Captured after pupil dilation
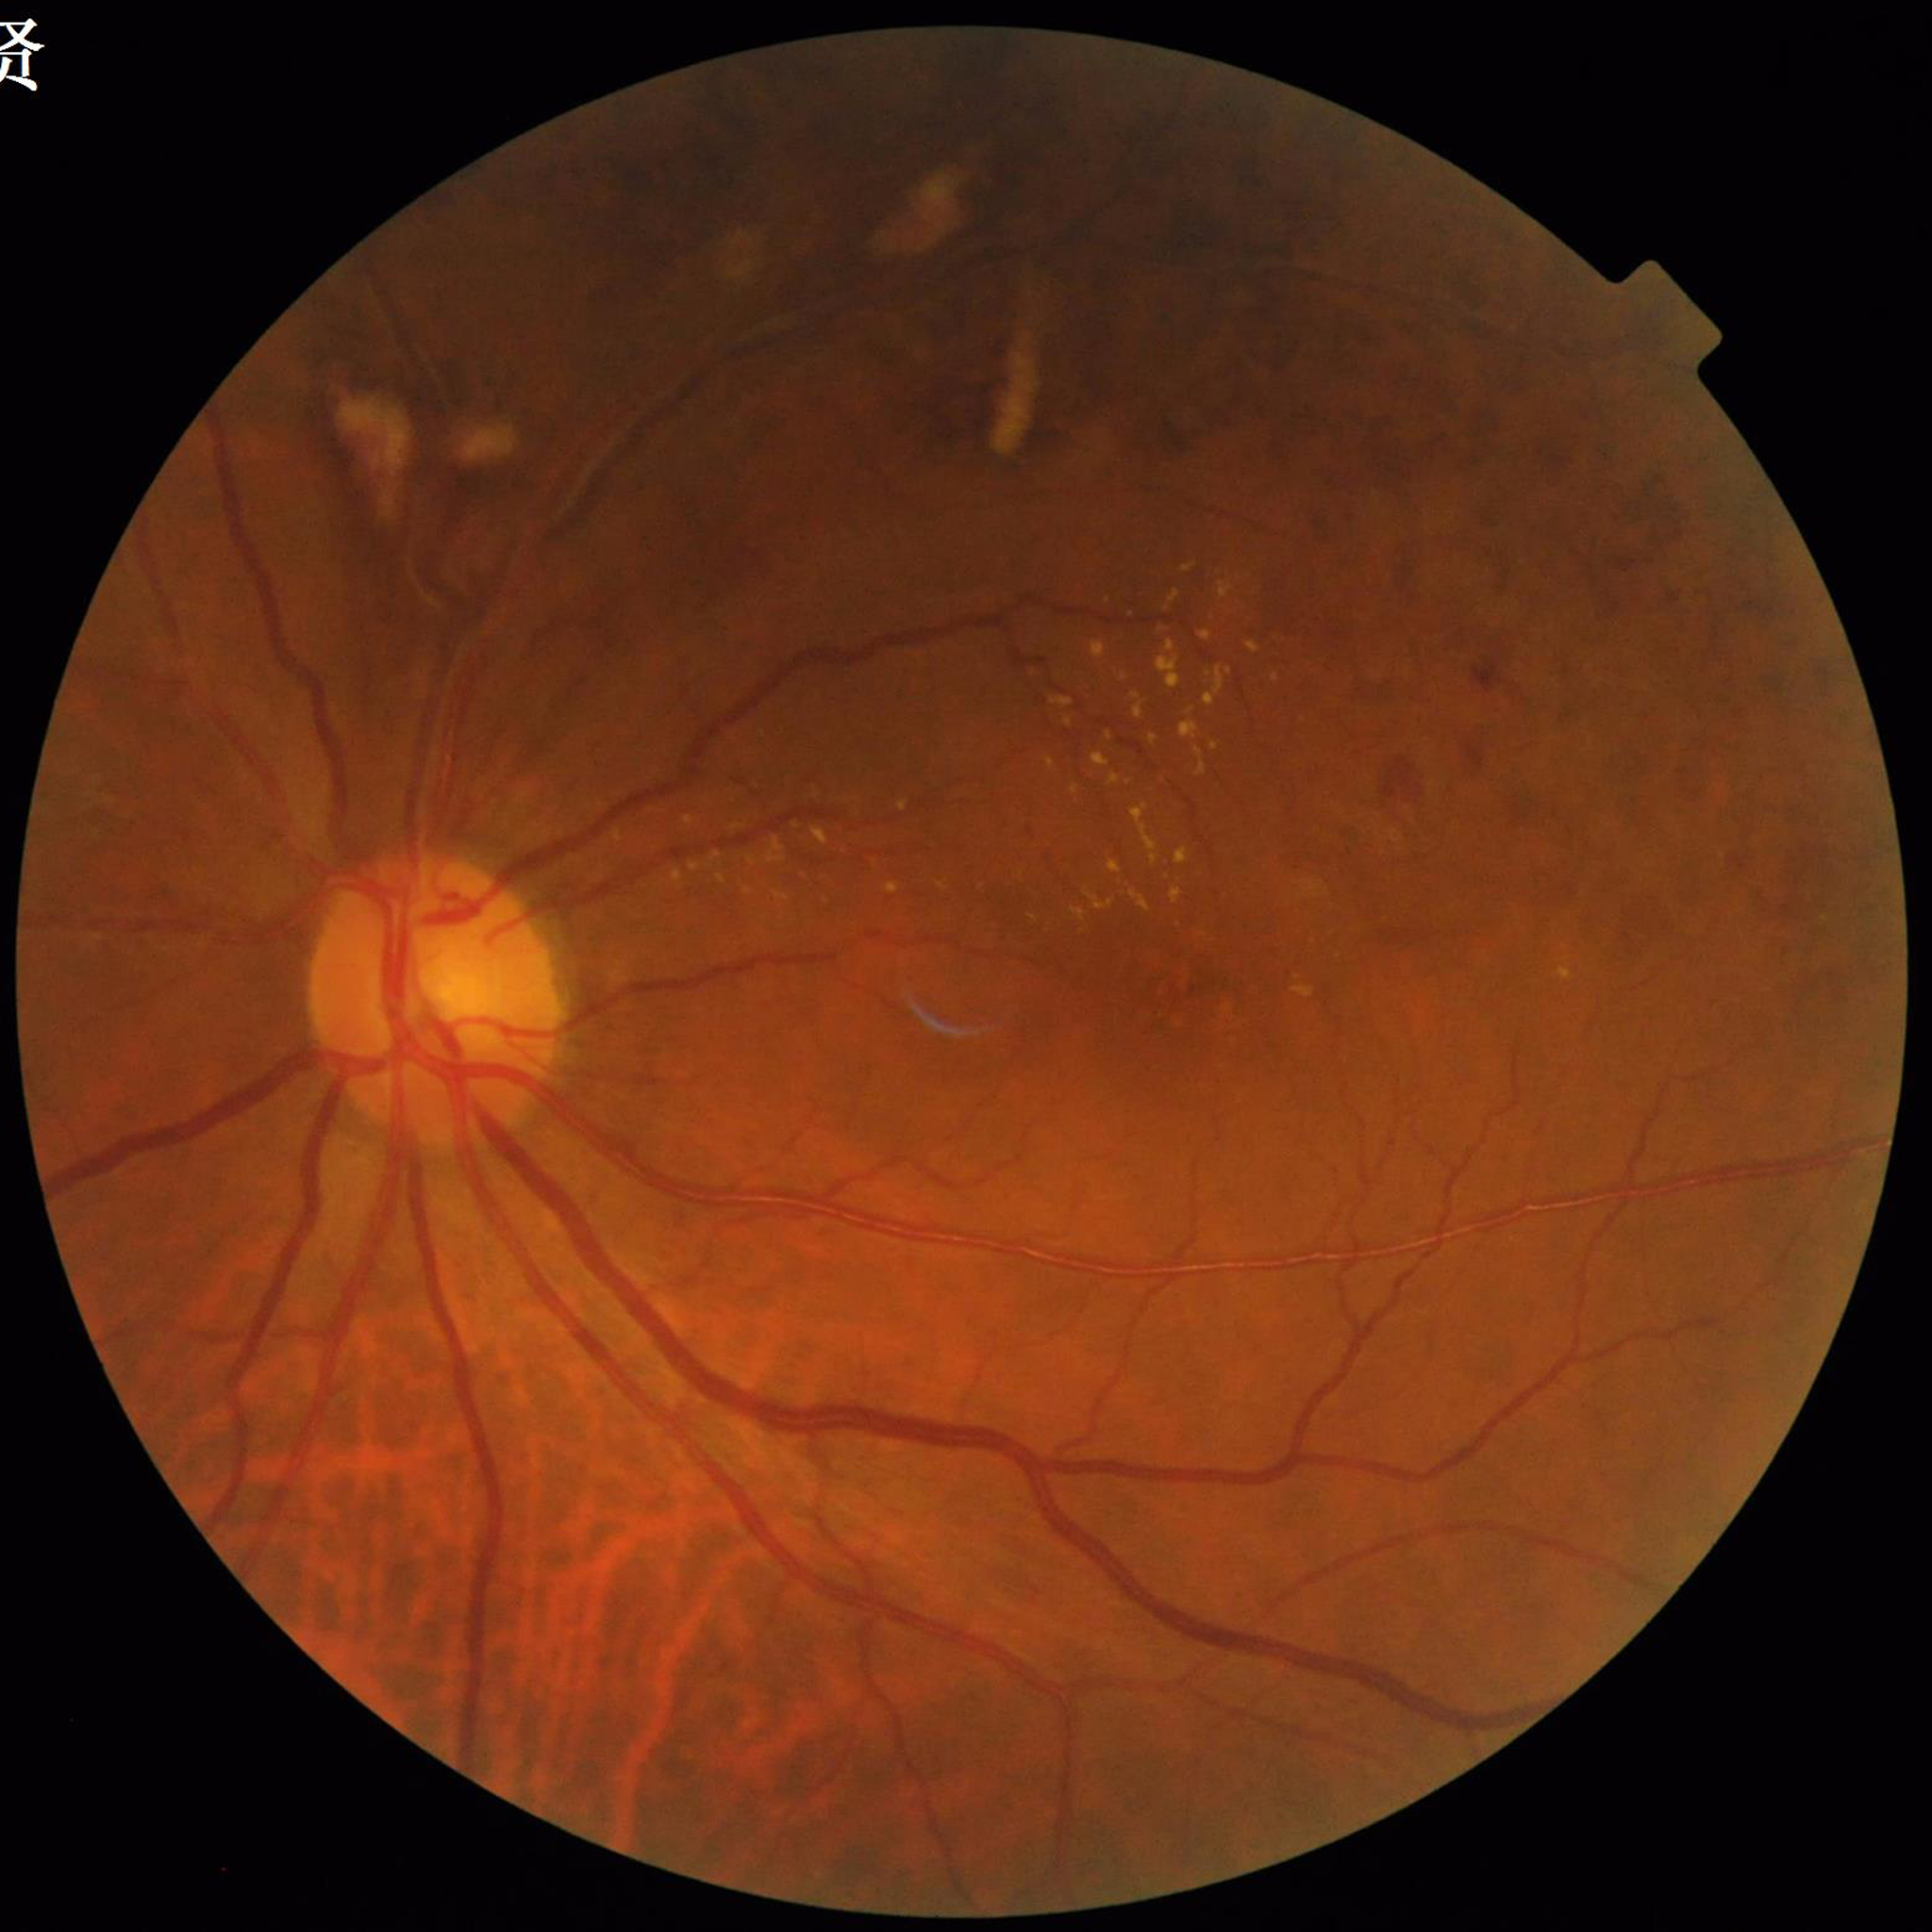
Automated quality assessment: no blur, contrast adequate, illumination and color satisfactory.
Color fundus photograph from a patient diagnosed with AMD.